Nonmydriatic fundus photograph · DR severity per modified Davis staging:
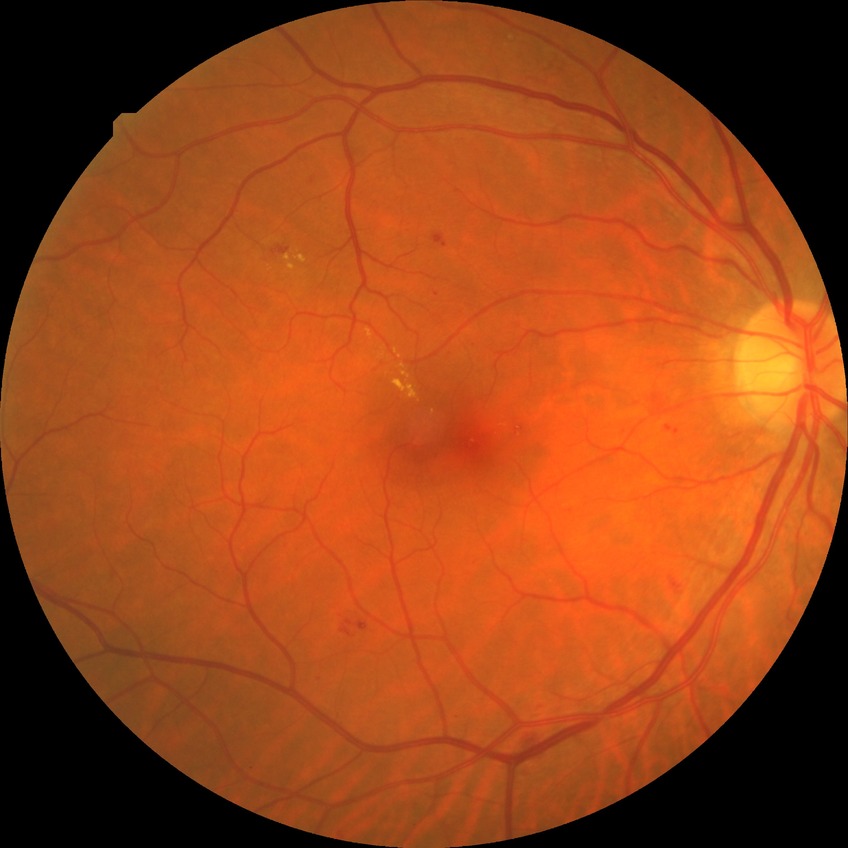
Diabetic retinopathy (DR): SDR (simple diabetic retinopathy). DR class: non-proliferative diabetic retinopathy.